Wide-field fundus image from infant ROP screening:
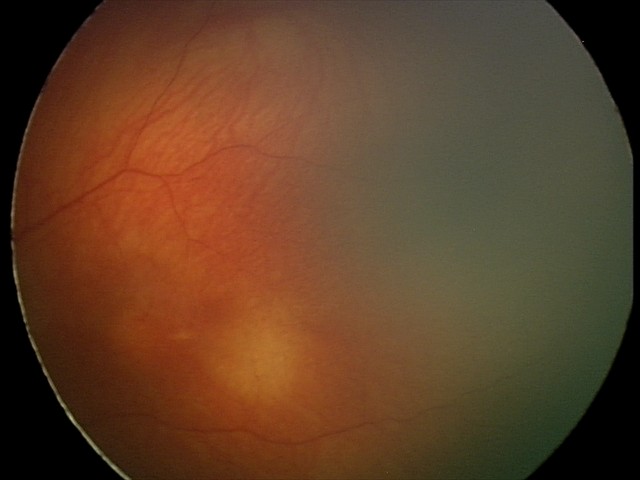 Screening examination diagnosed as physiological.